Captured on a Remidio smartphone fundus camera; fundus photo.
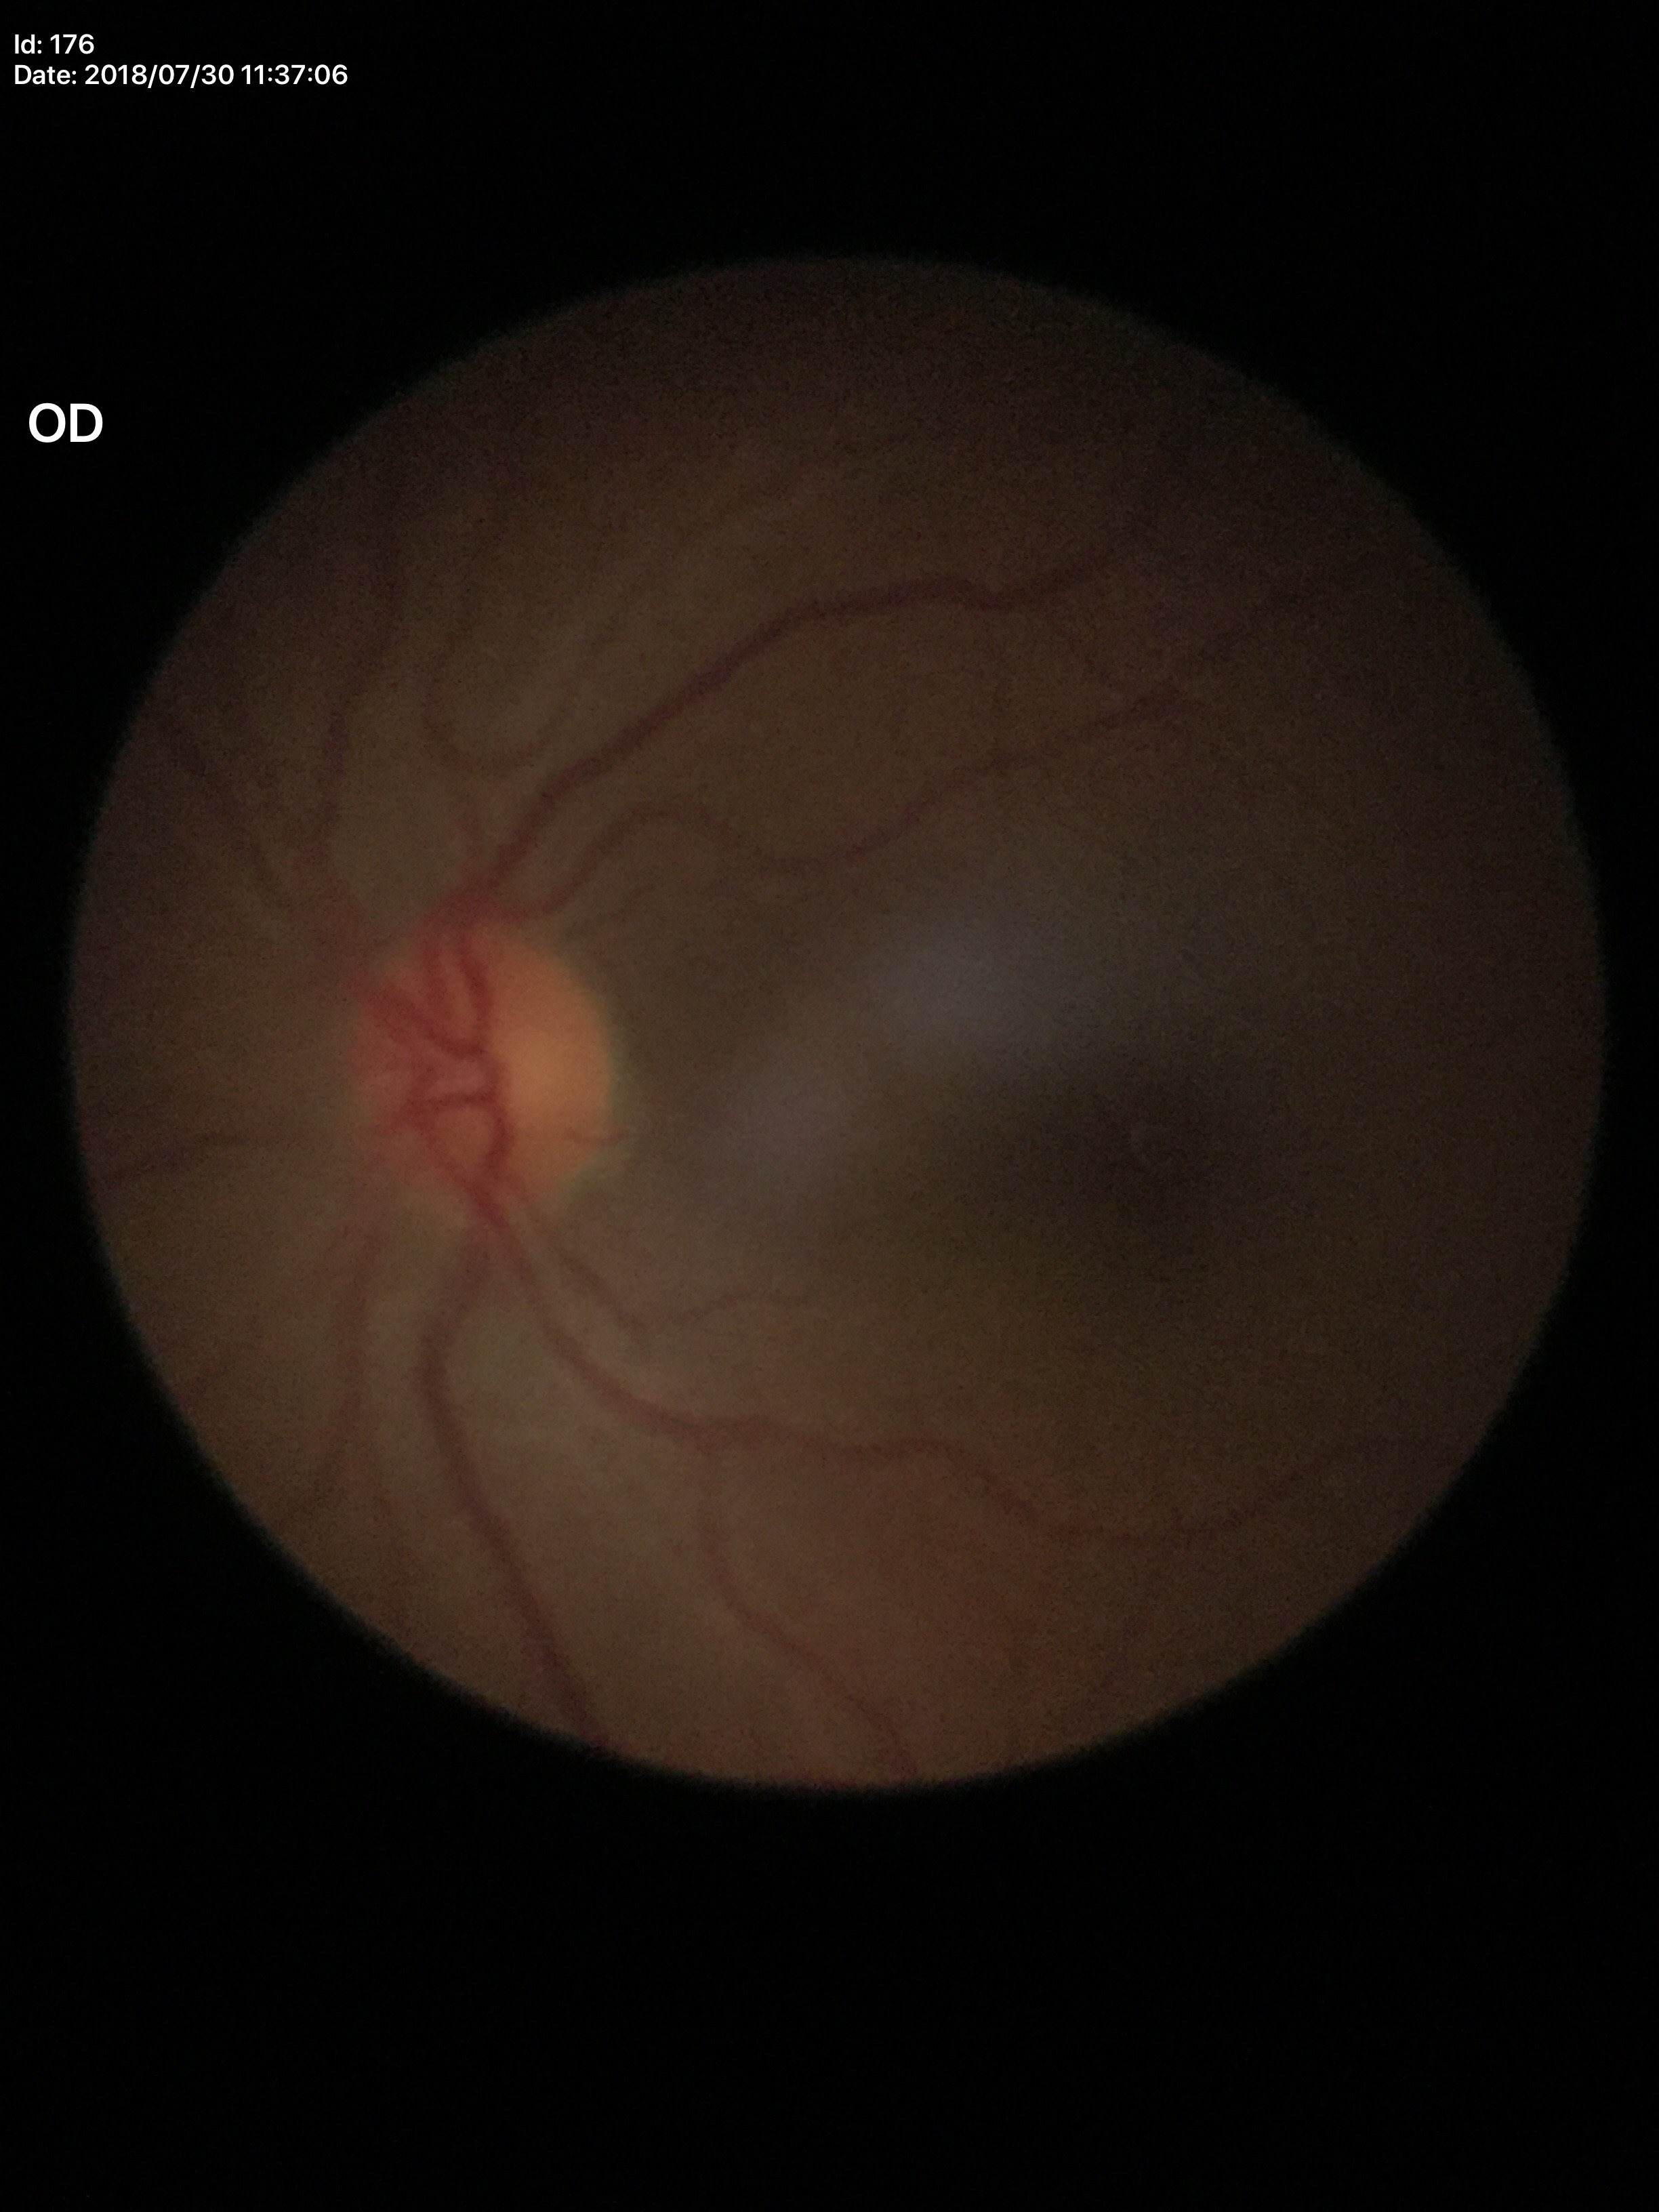 {"acdr": "0.19", "vcdr": "0.42", "glaucoma_decision": "no suspicious findings"}